Posterior pole color fundus photograph, 848 by 848 pixels.
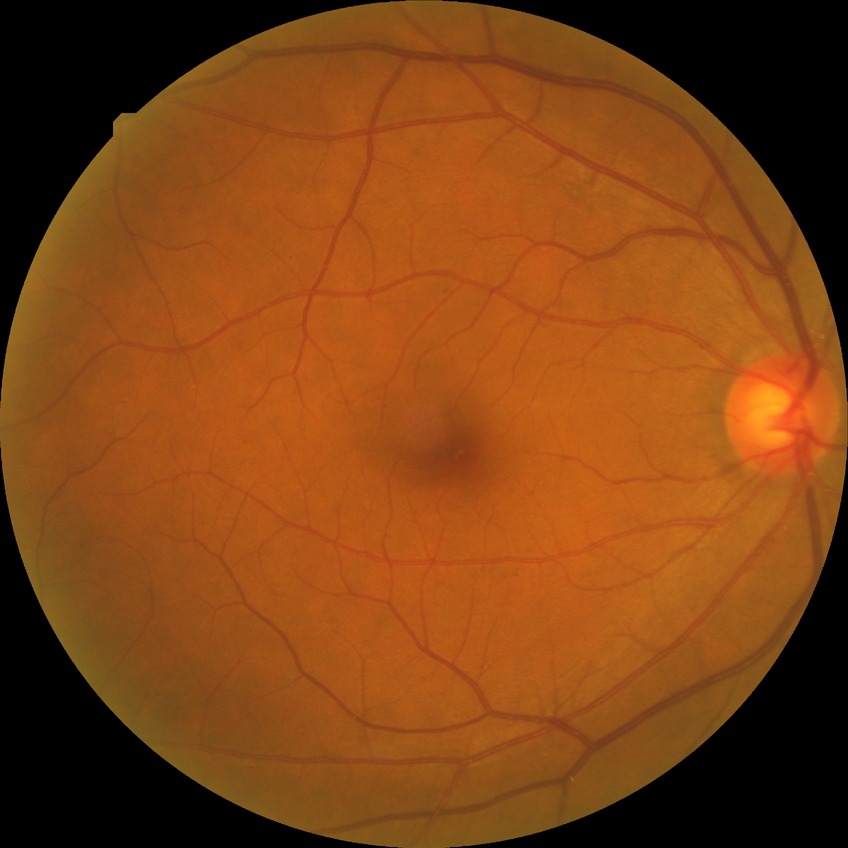 Diabetic retinopathy (DR) is SDR (simple diabetic retinopathy).